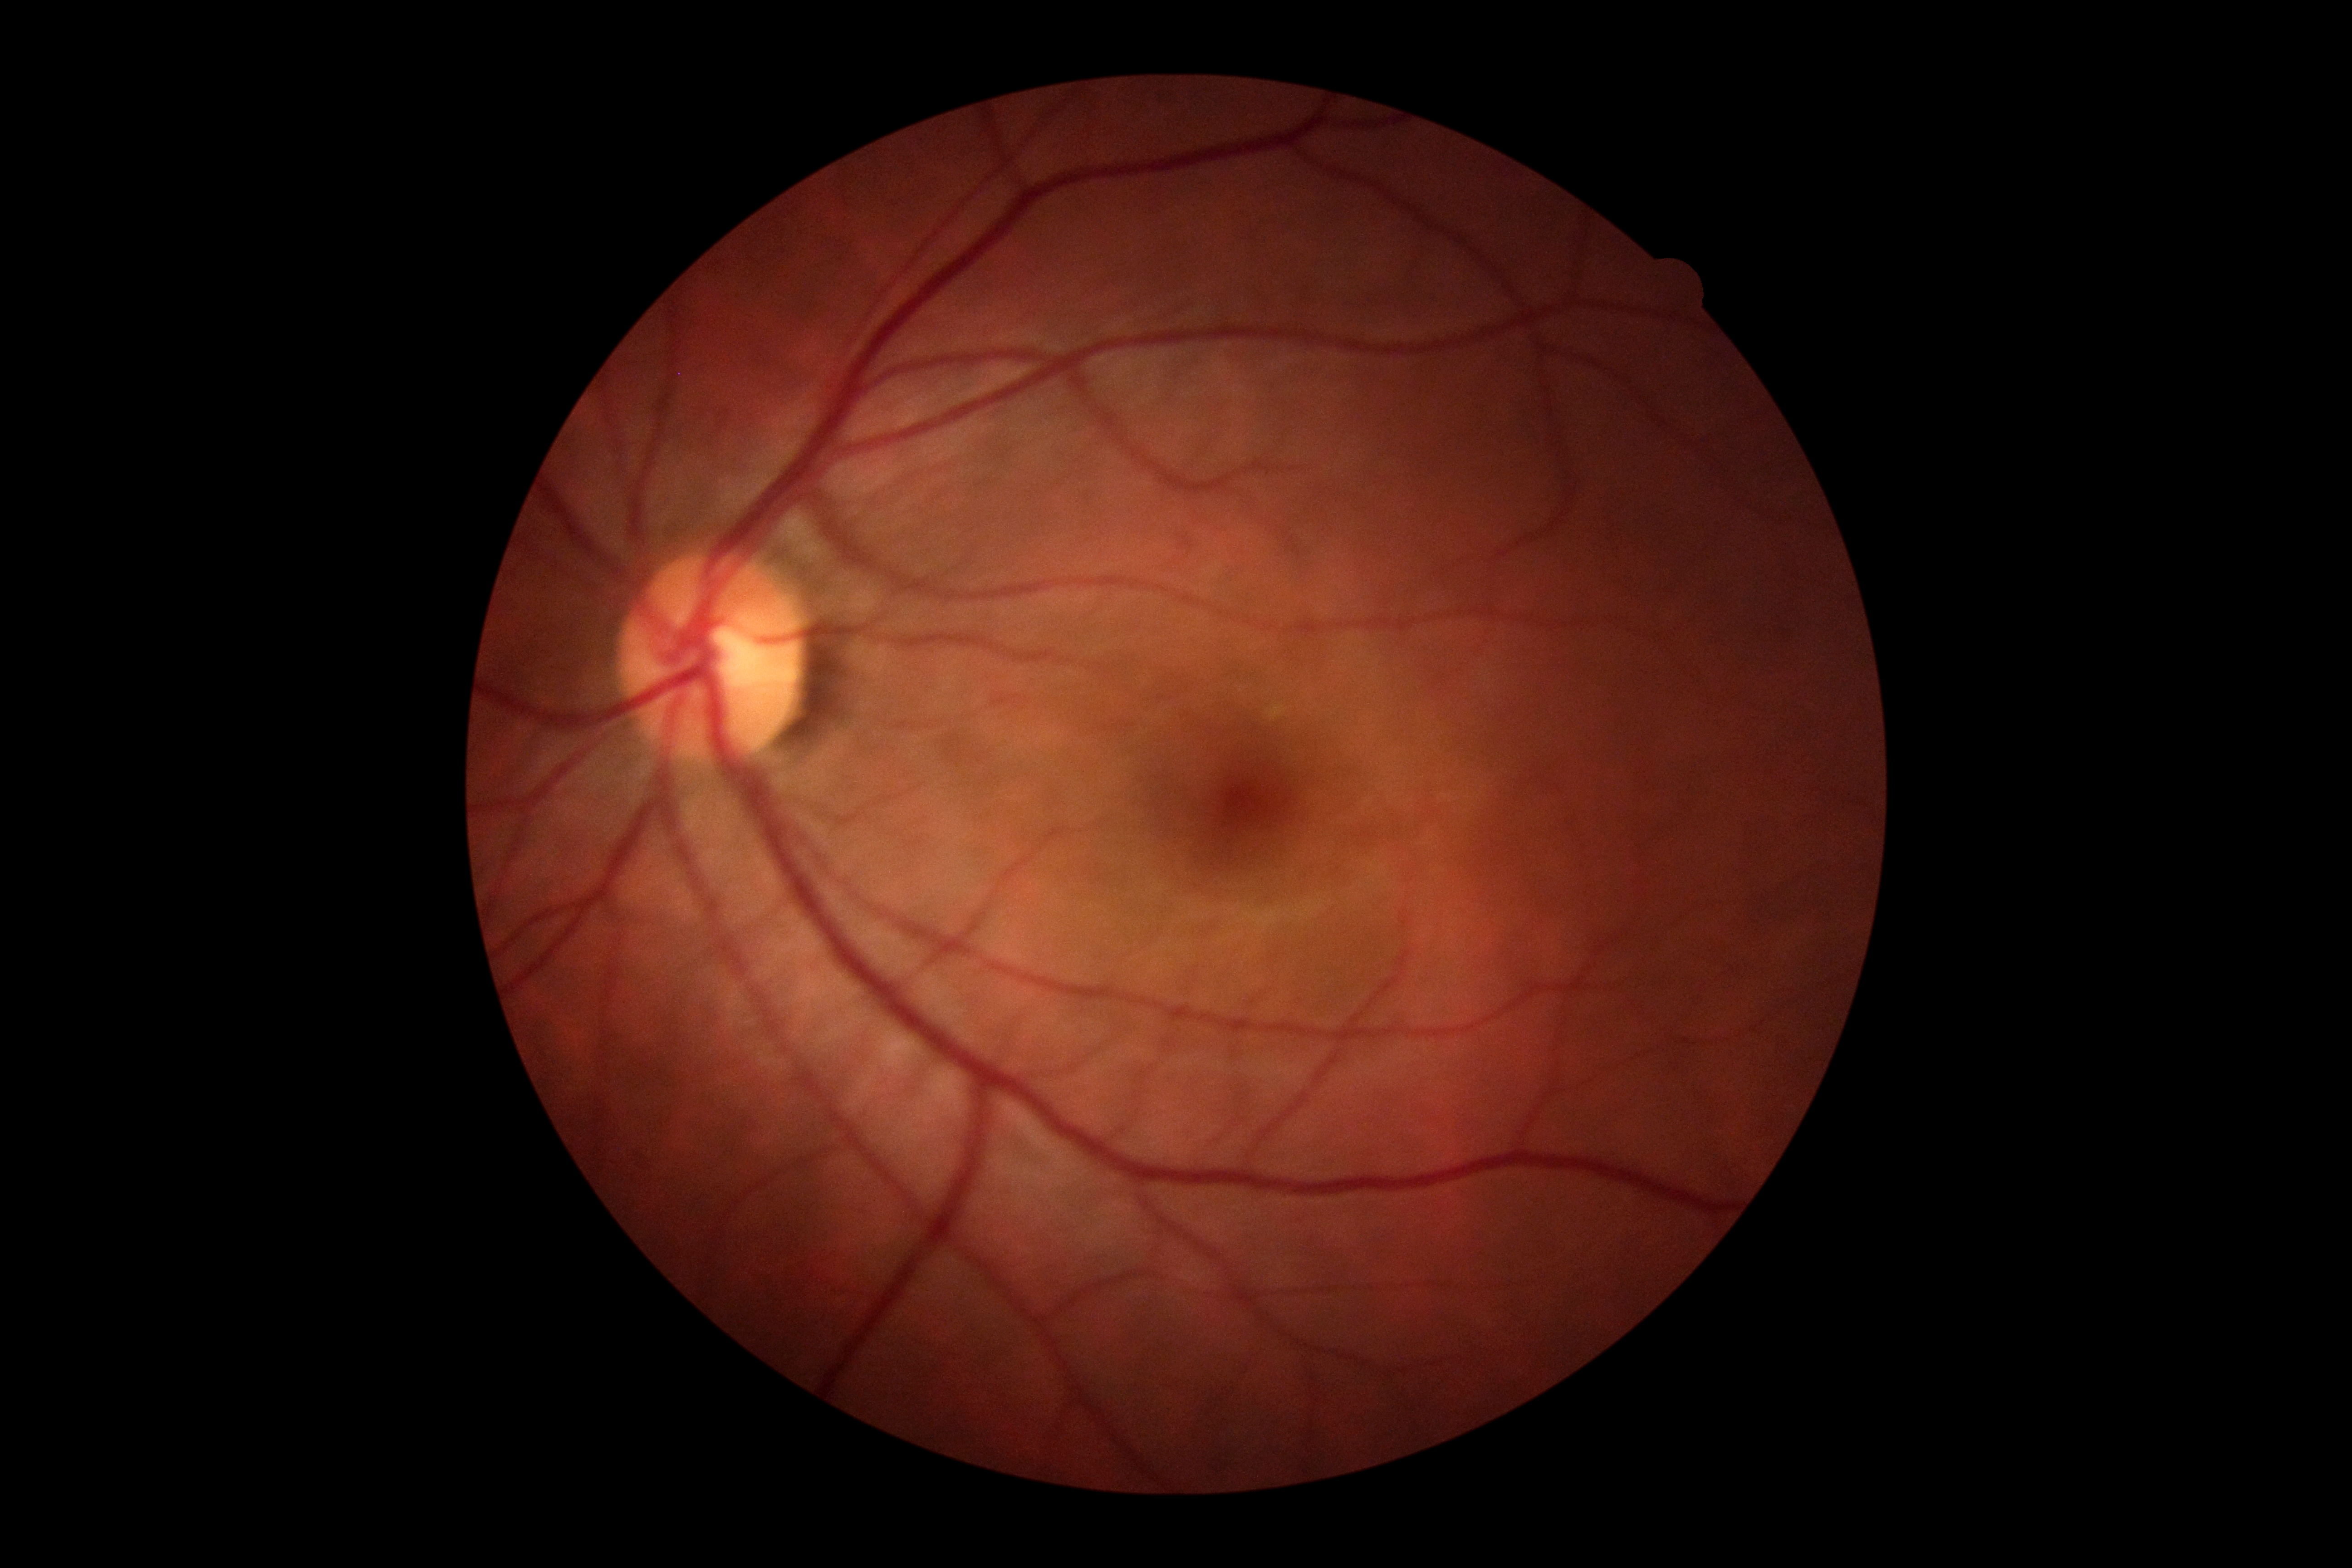

DR grade: 0/4.